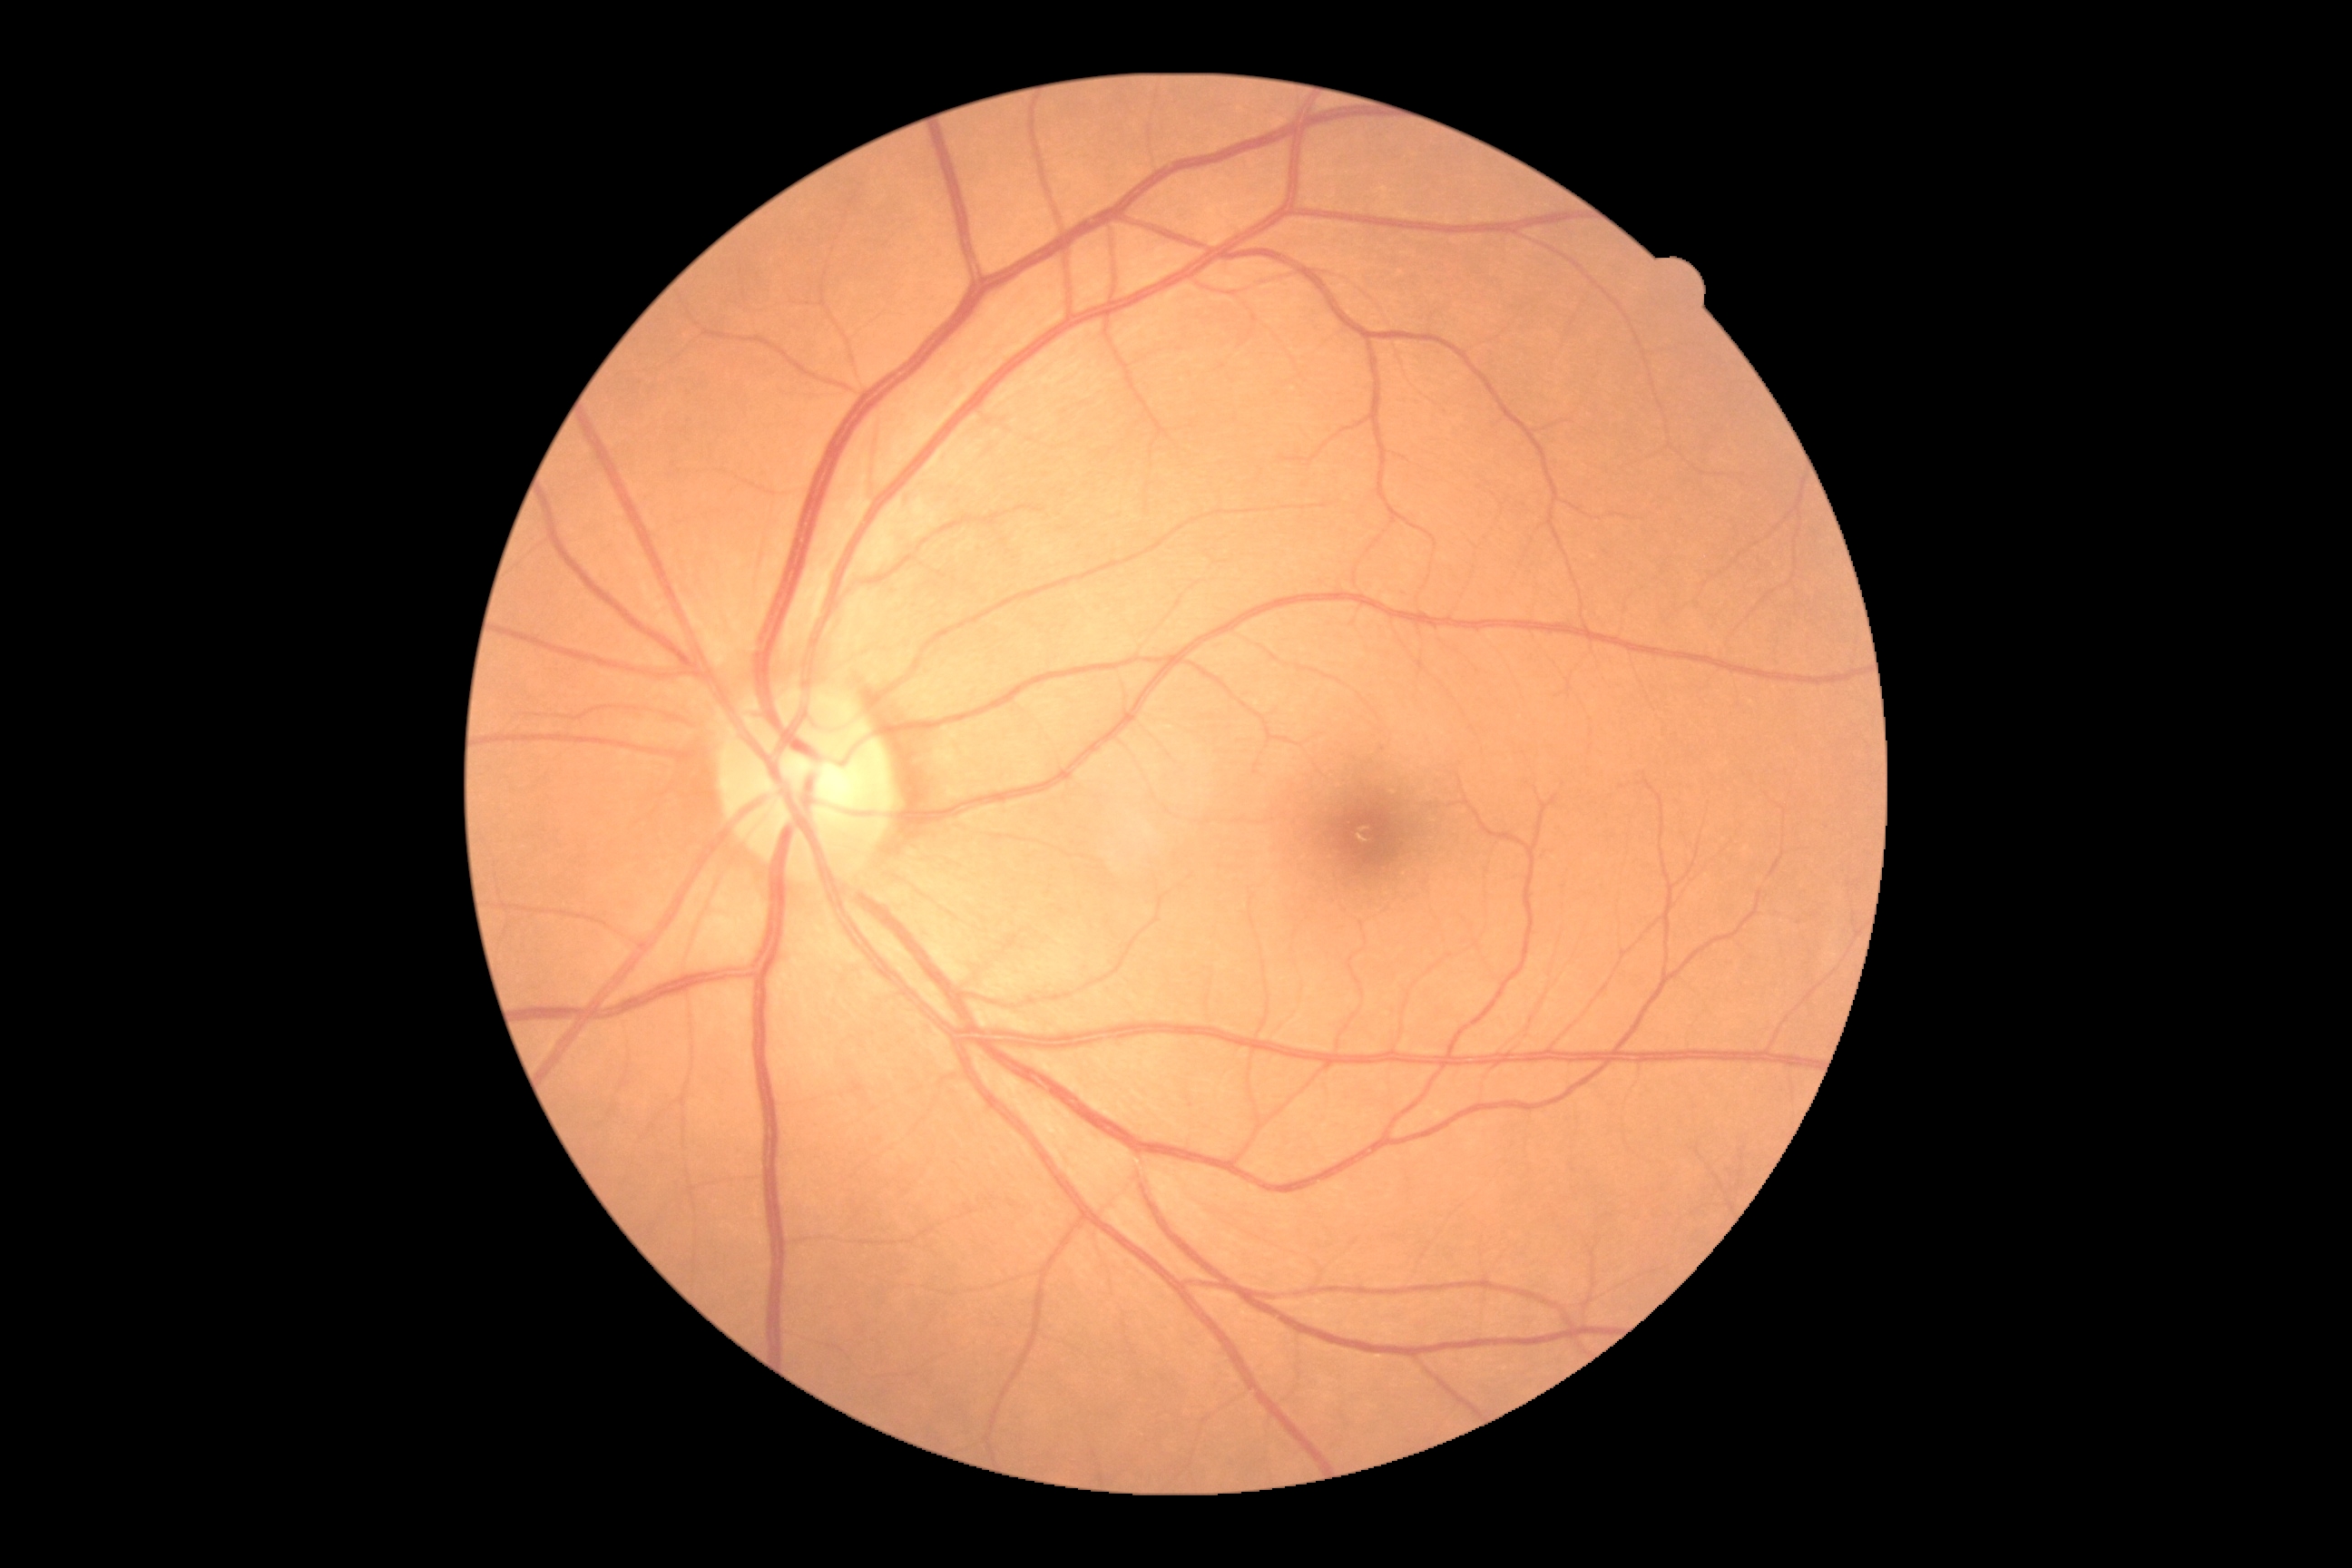 Diabetic retinopathy (DR): grade 0 (no apparent retinopathy).